NIDEK AFC-230, without pupil dilation
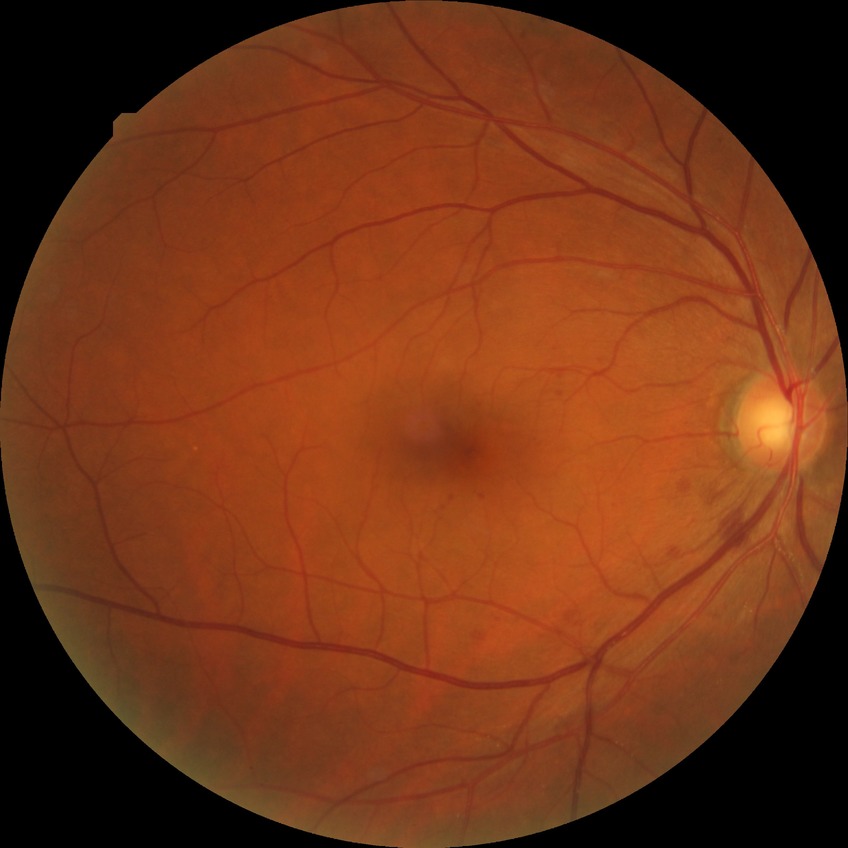

Retinopathy stage is simple diabetic retinopathy.